1380x1382px:
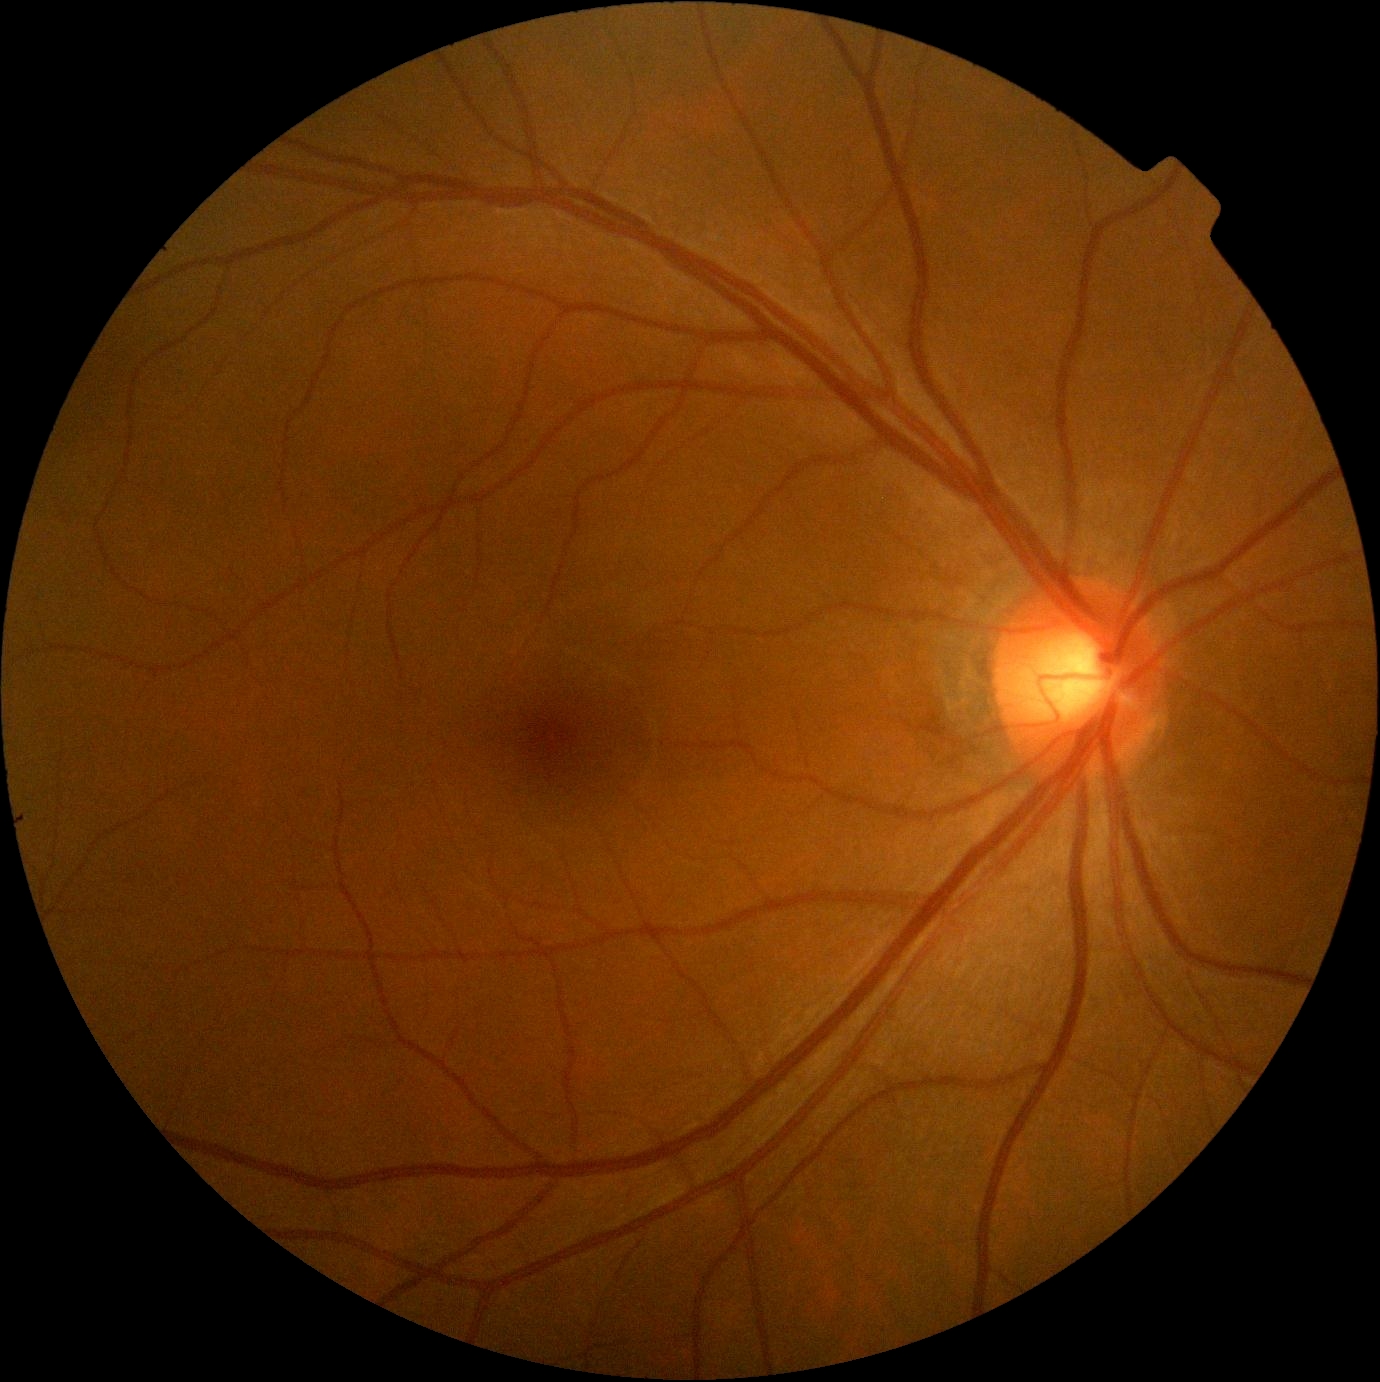 DR grade = 0.